Camera: Clarity RetCam 3 (130° FOV). Infant wide-field retinal image
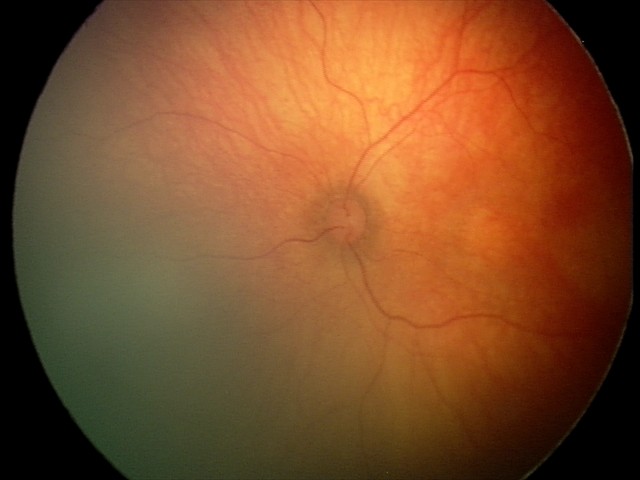 Assessment: no abnormalities